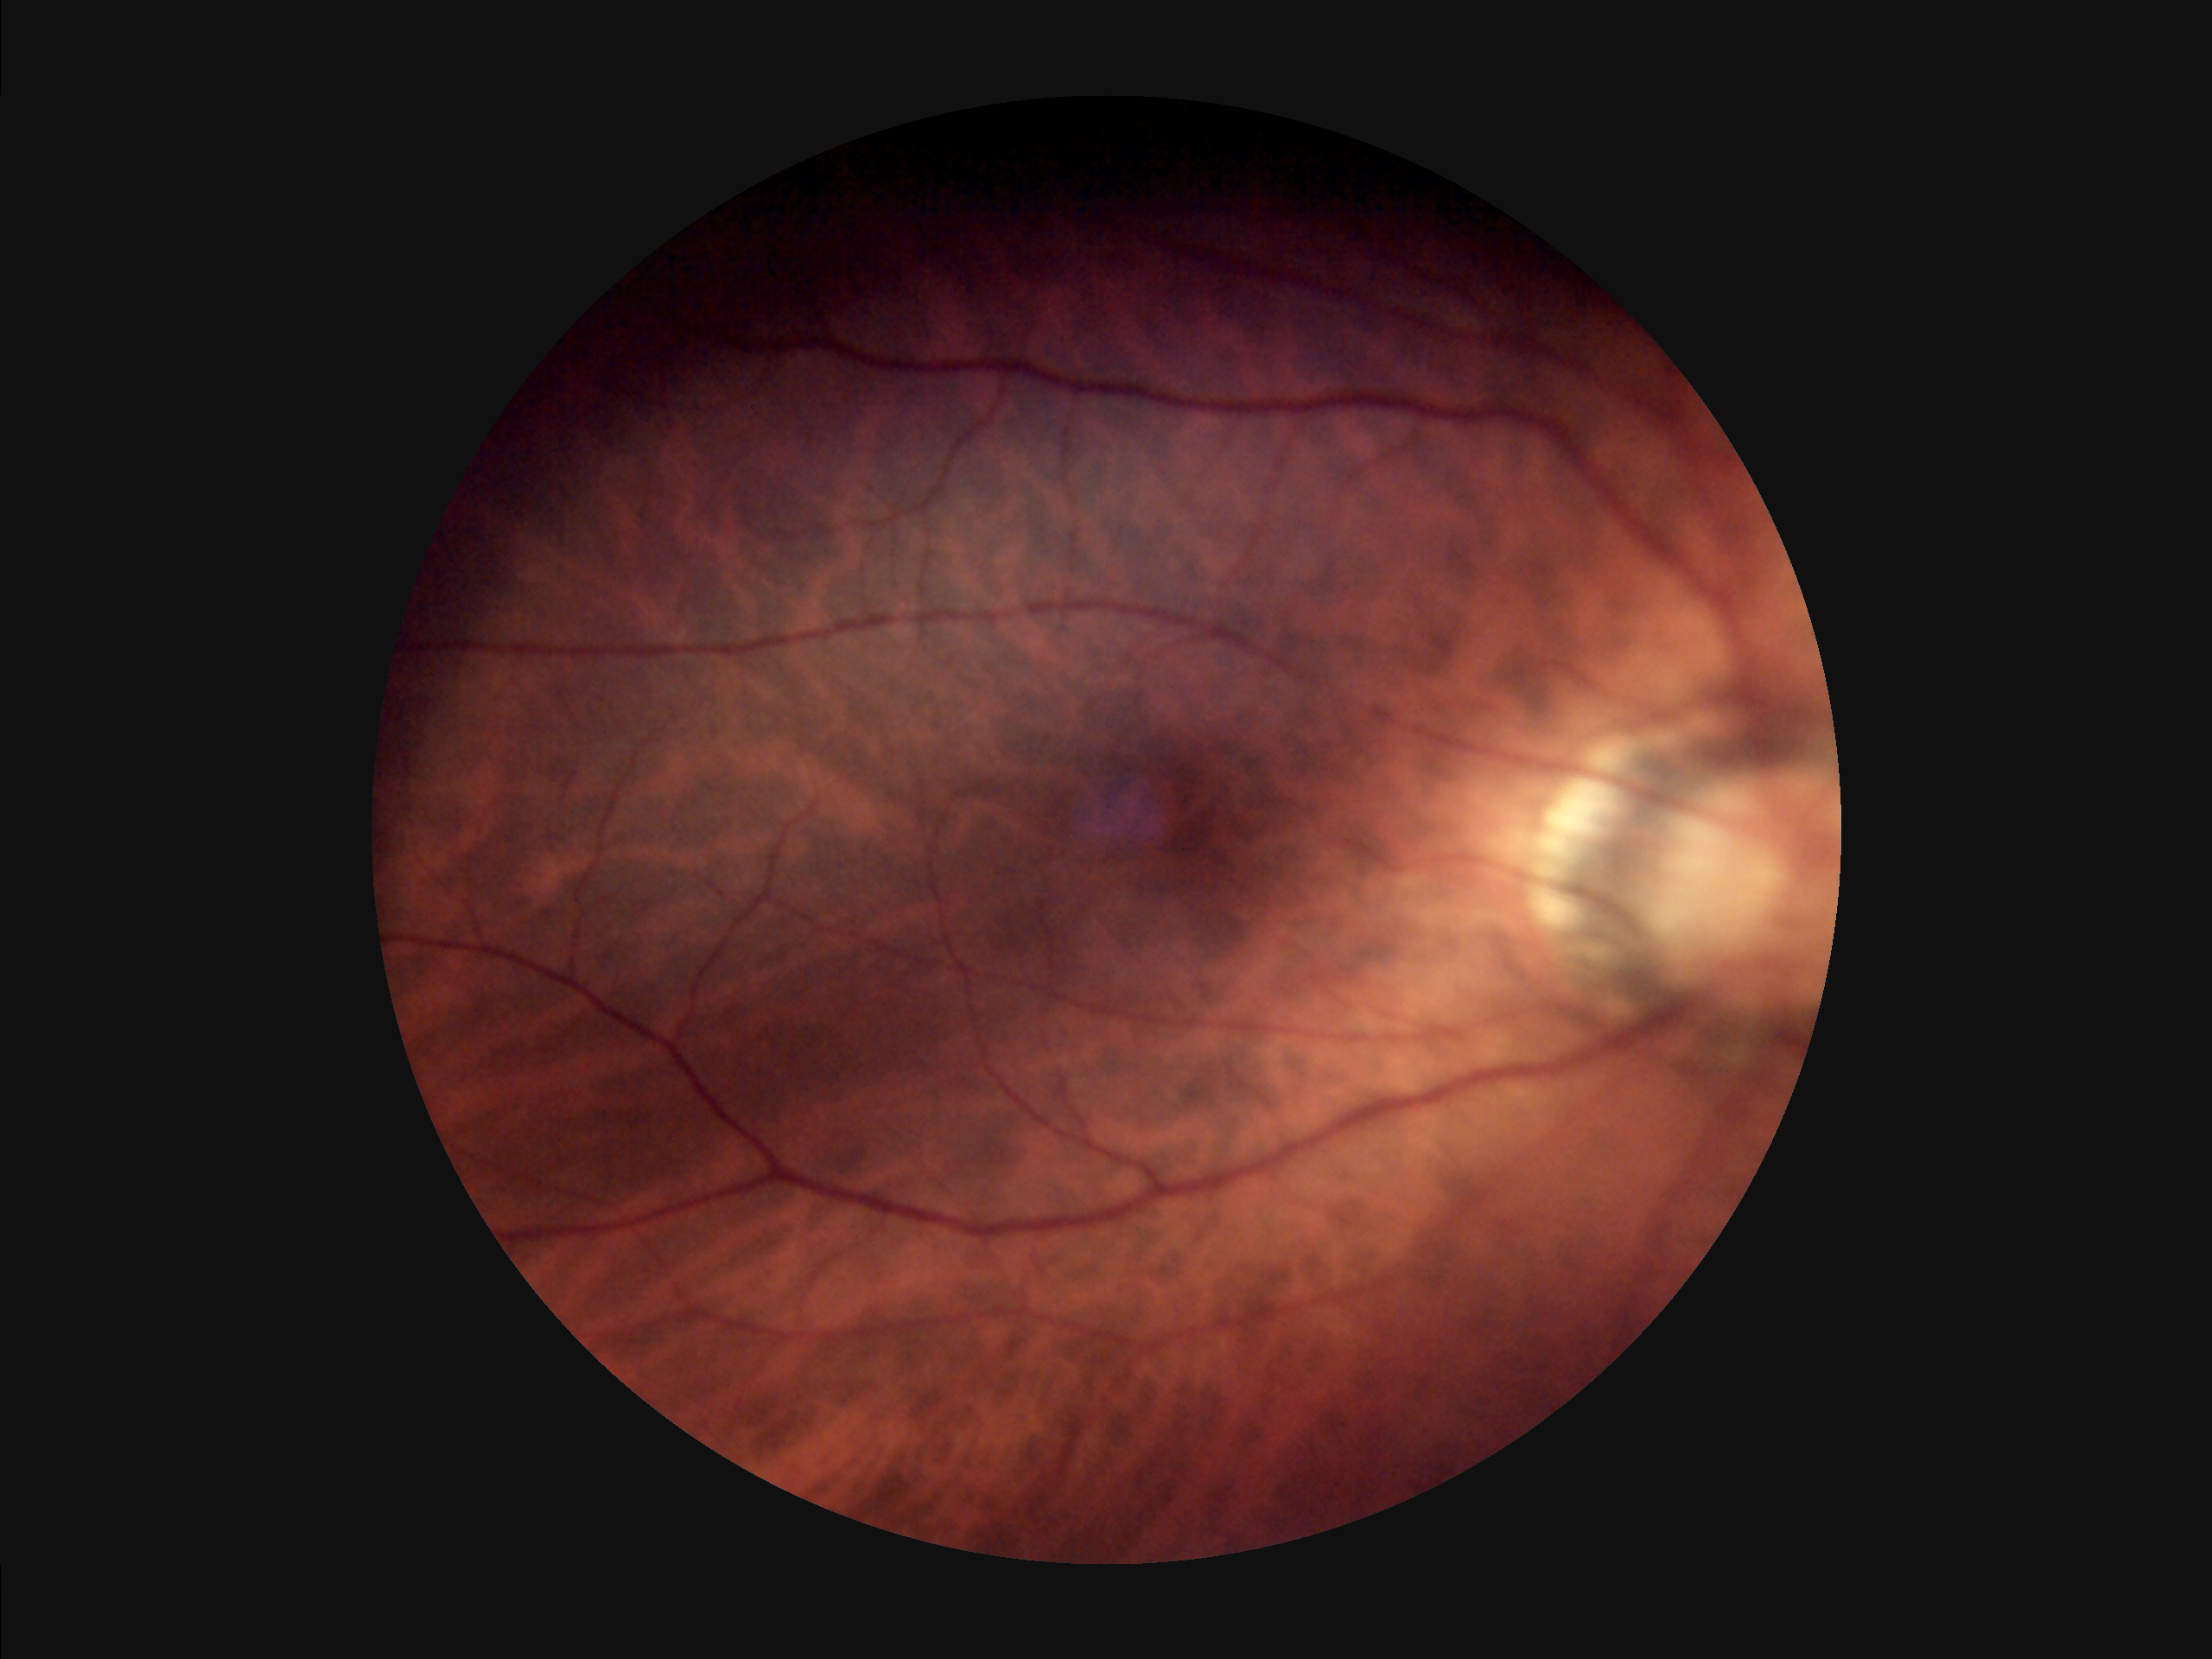
Illumination and color are suboptimal.
Image is sharp throughout the field.
Overall image quality is poor.